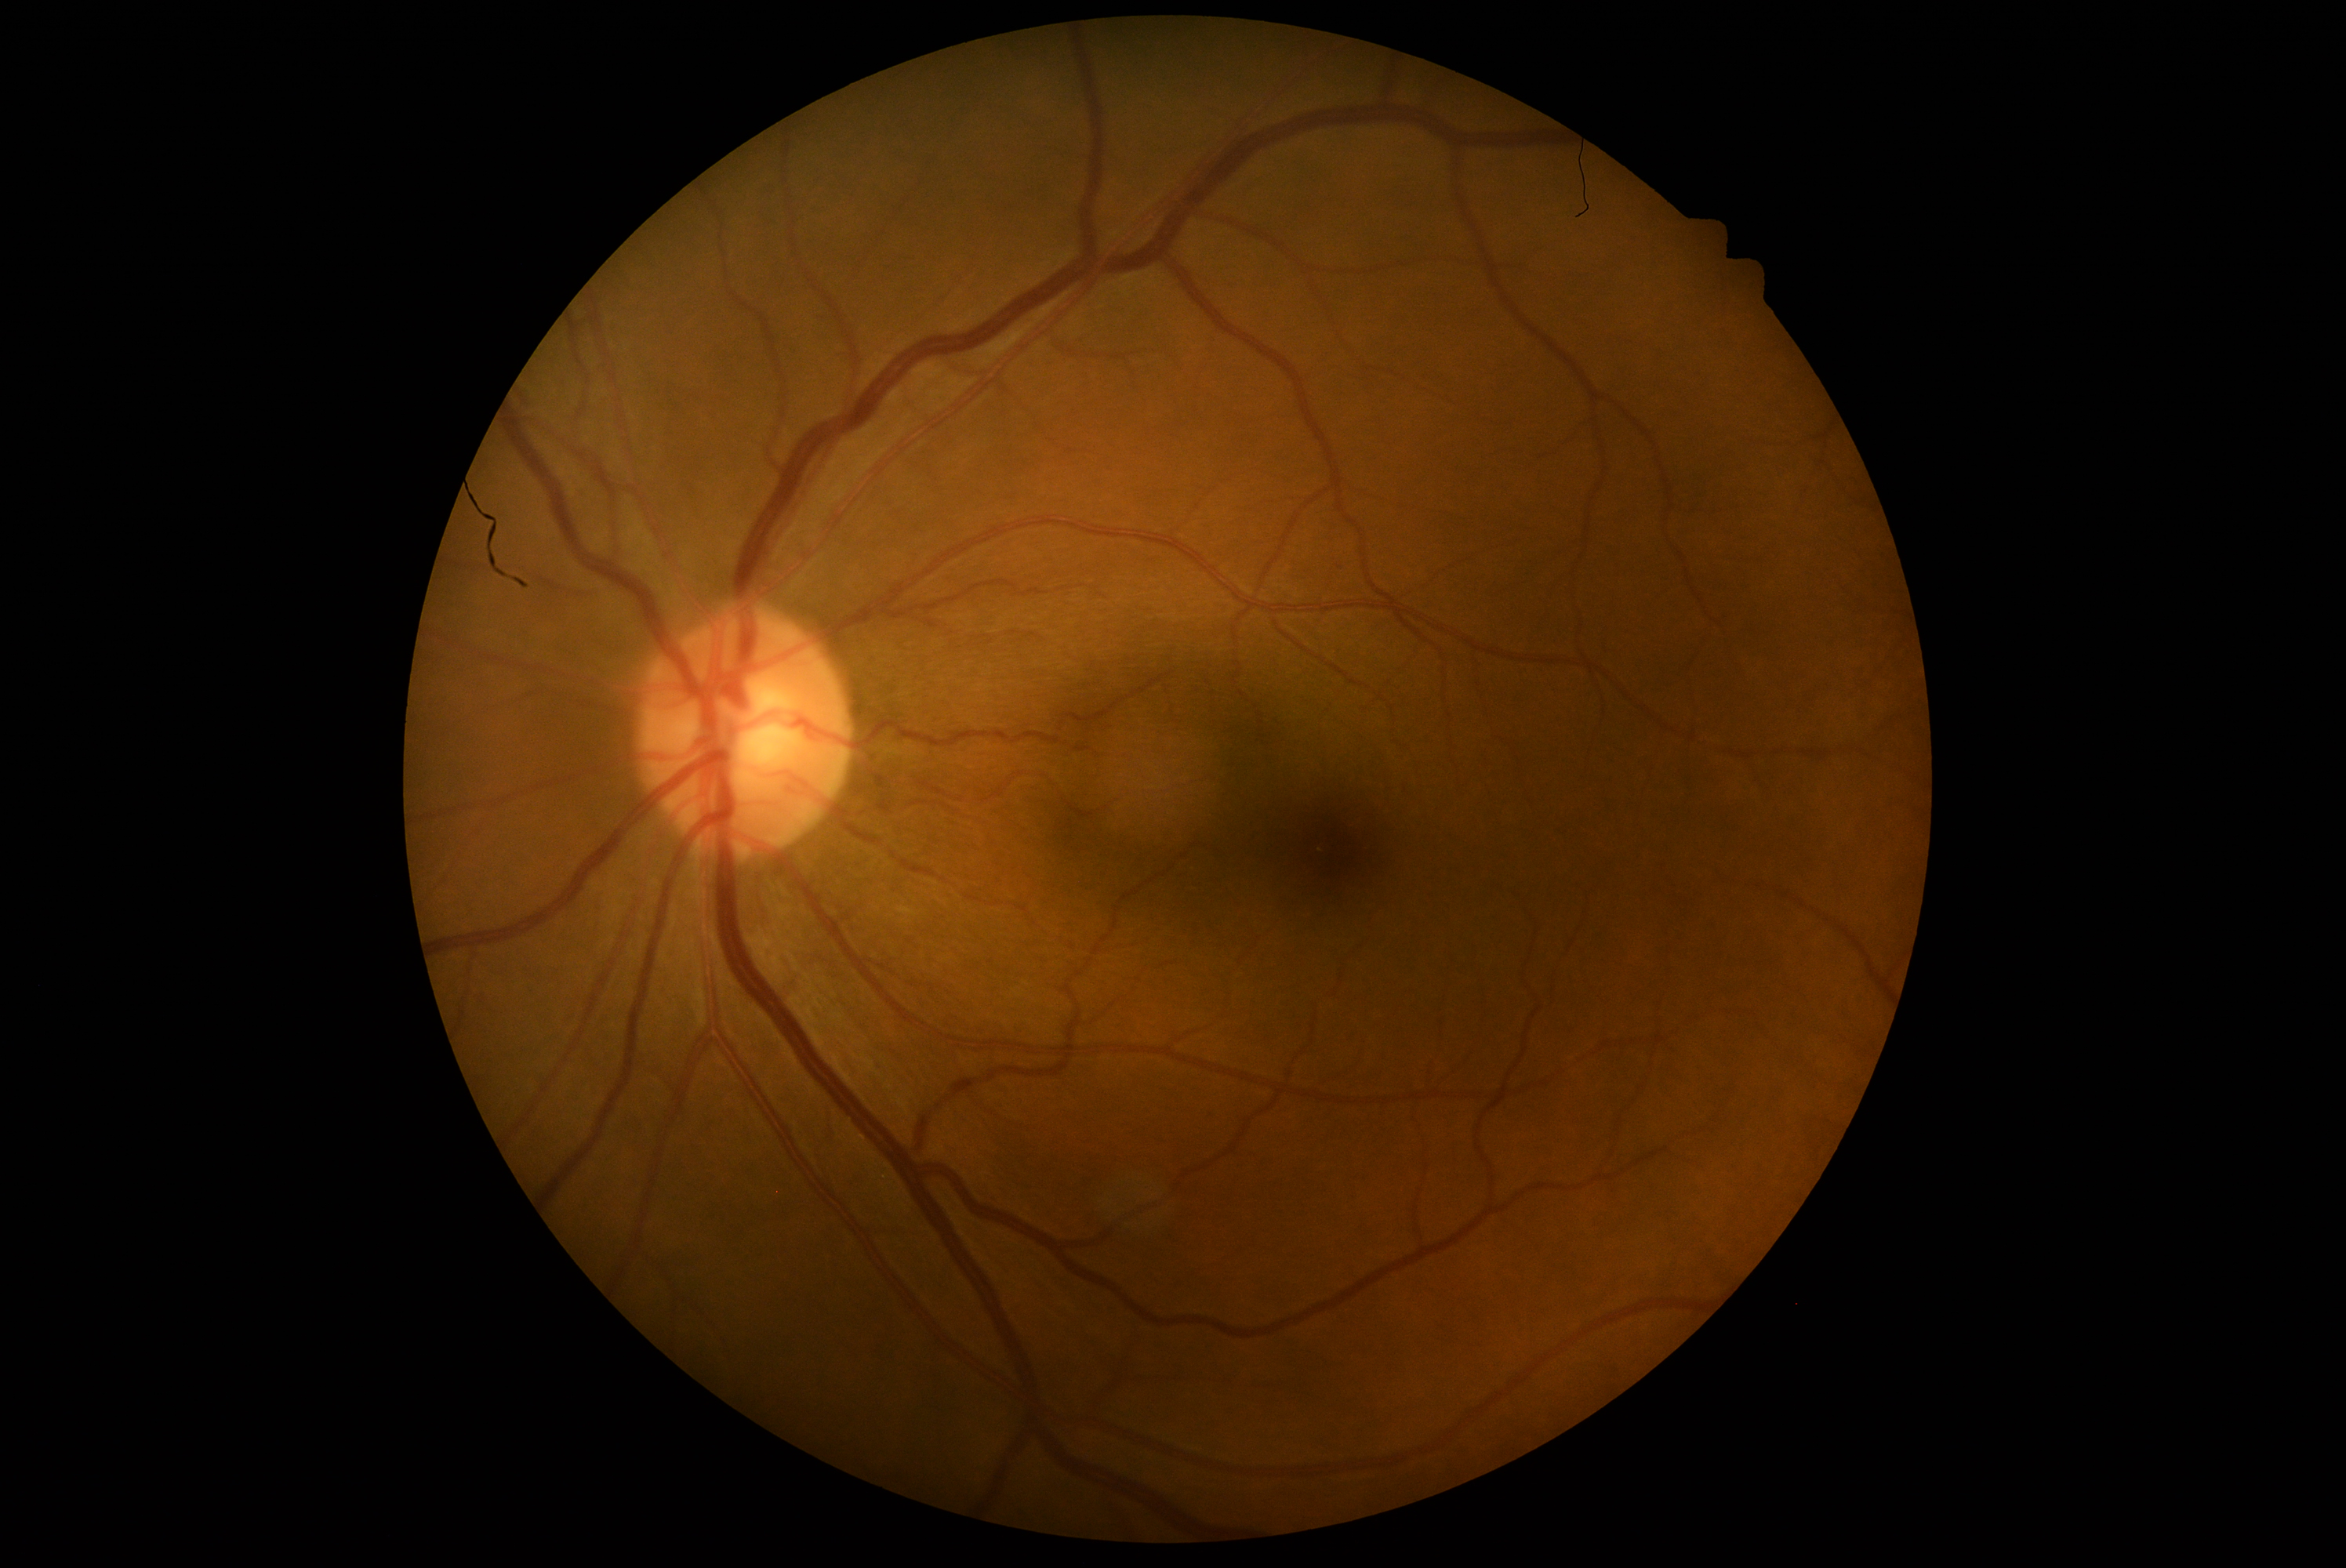 DR stage: 0.